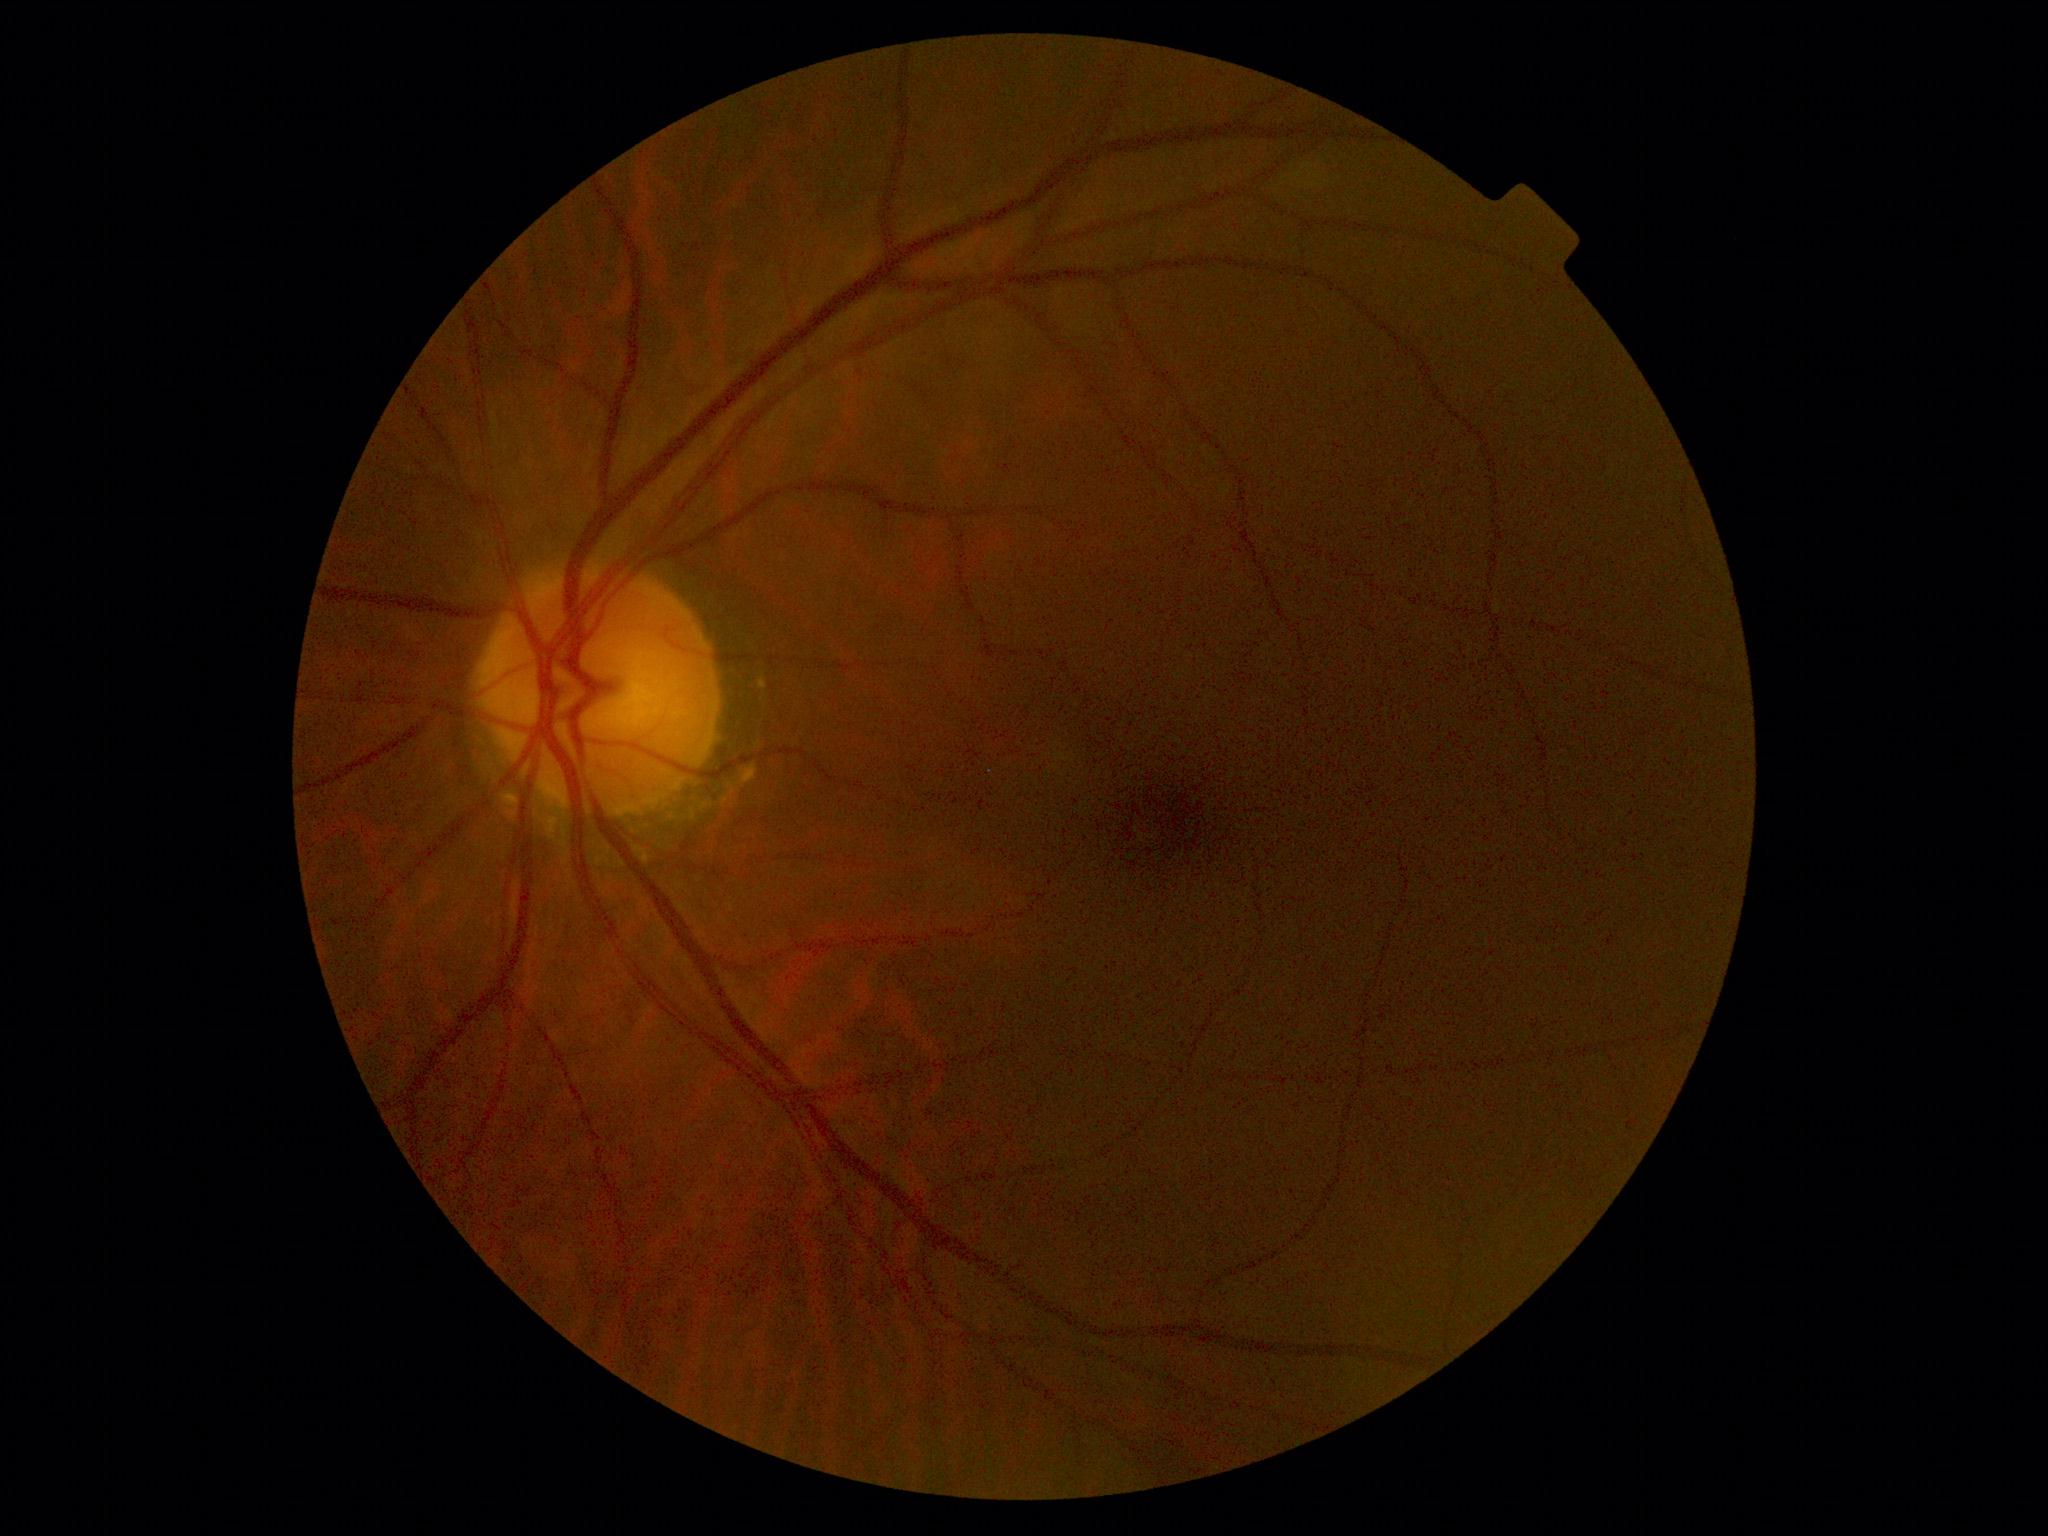

DR severity: grade 0.